45° FOV, 2212x1659px.
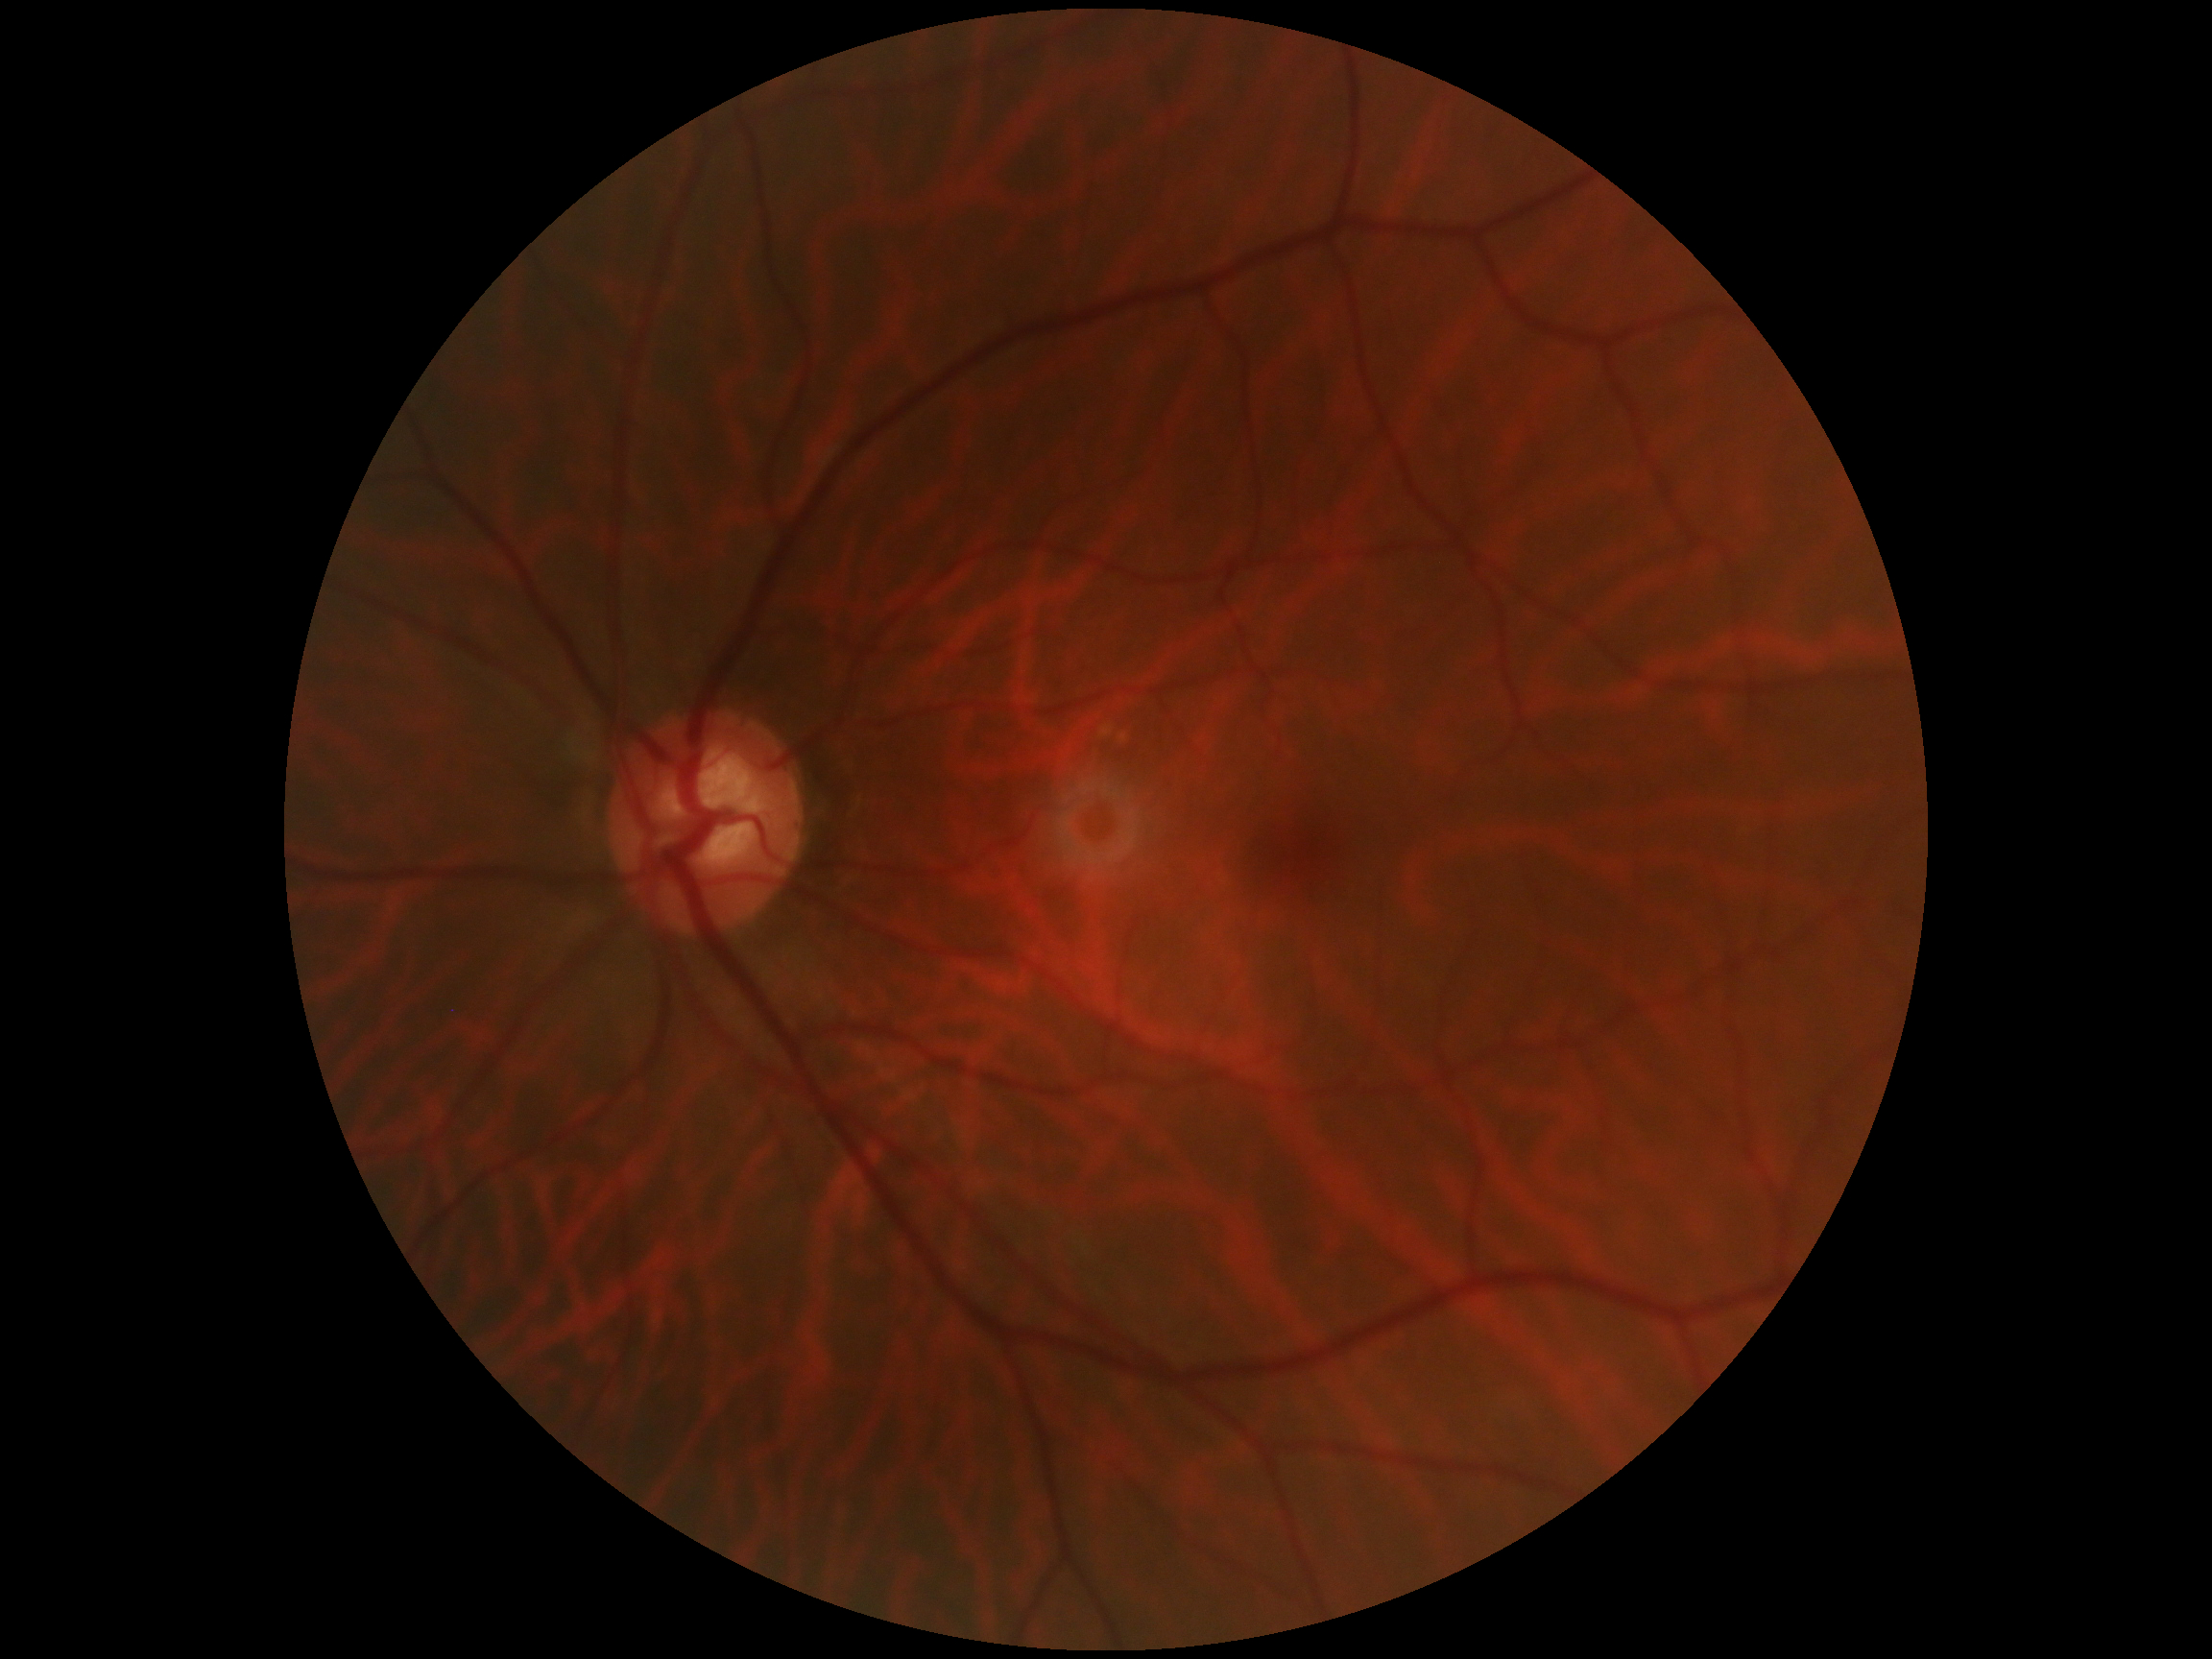
Diabetic retinopathy is grade 0 (no apparent retinopathy) — no visible signs of diabetic retinopathy.